Wide-field fundus photograph of an infant. Camera: Natus RetCam Envision (130° FOV)
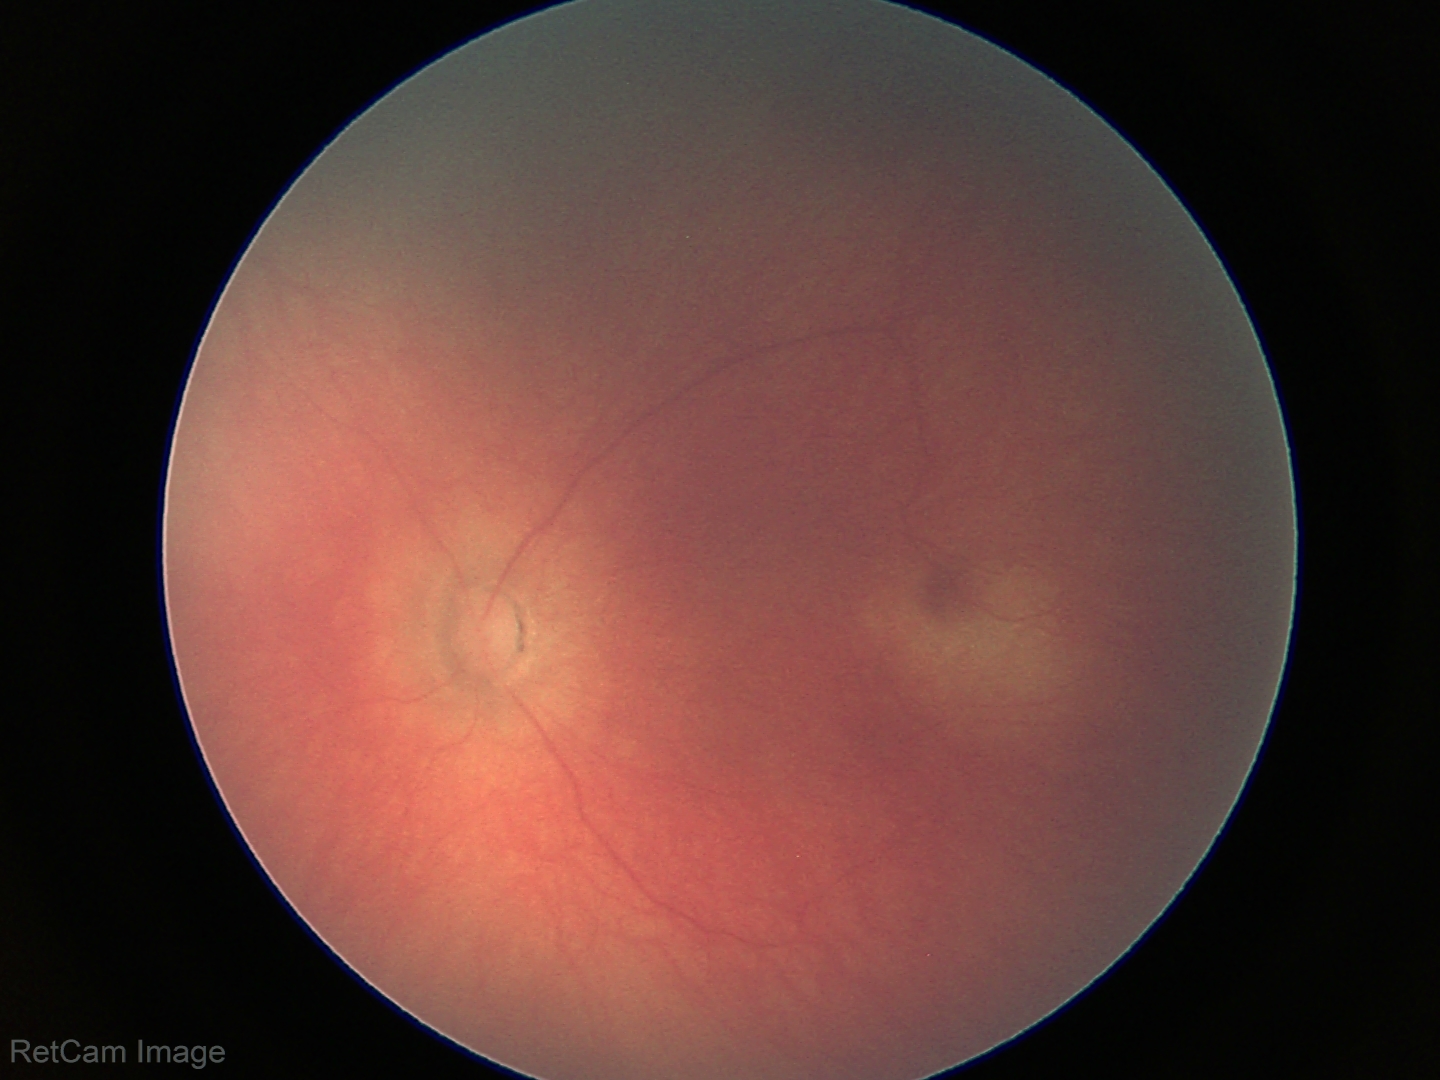

Examination with physiological retinal findings.